45° field of view · color fundus photograph.
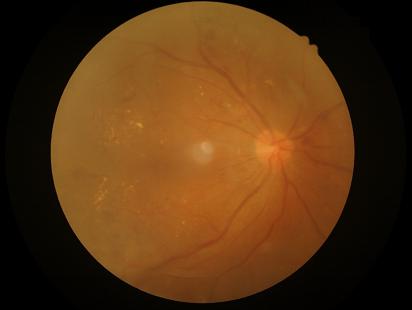

{"overall_quality": "inadequate", "illumination": "even", "contrast": "satisfactory", "clarity": "reduced"}